512 x 512 pixels. Fundus photo
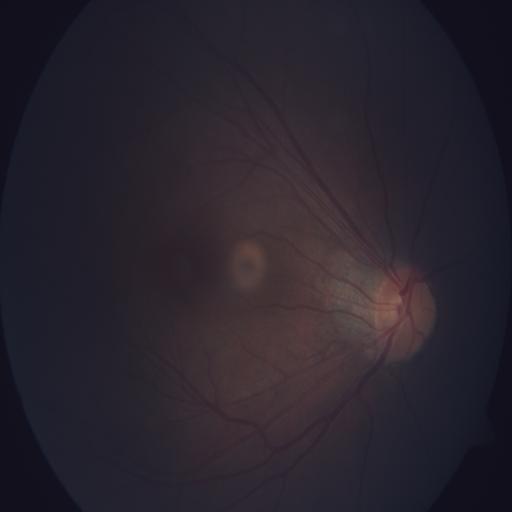

Findings:
- chorioretinitis (CRS)